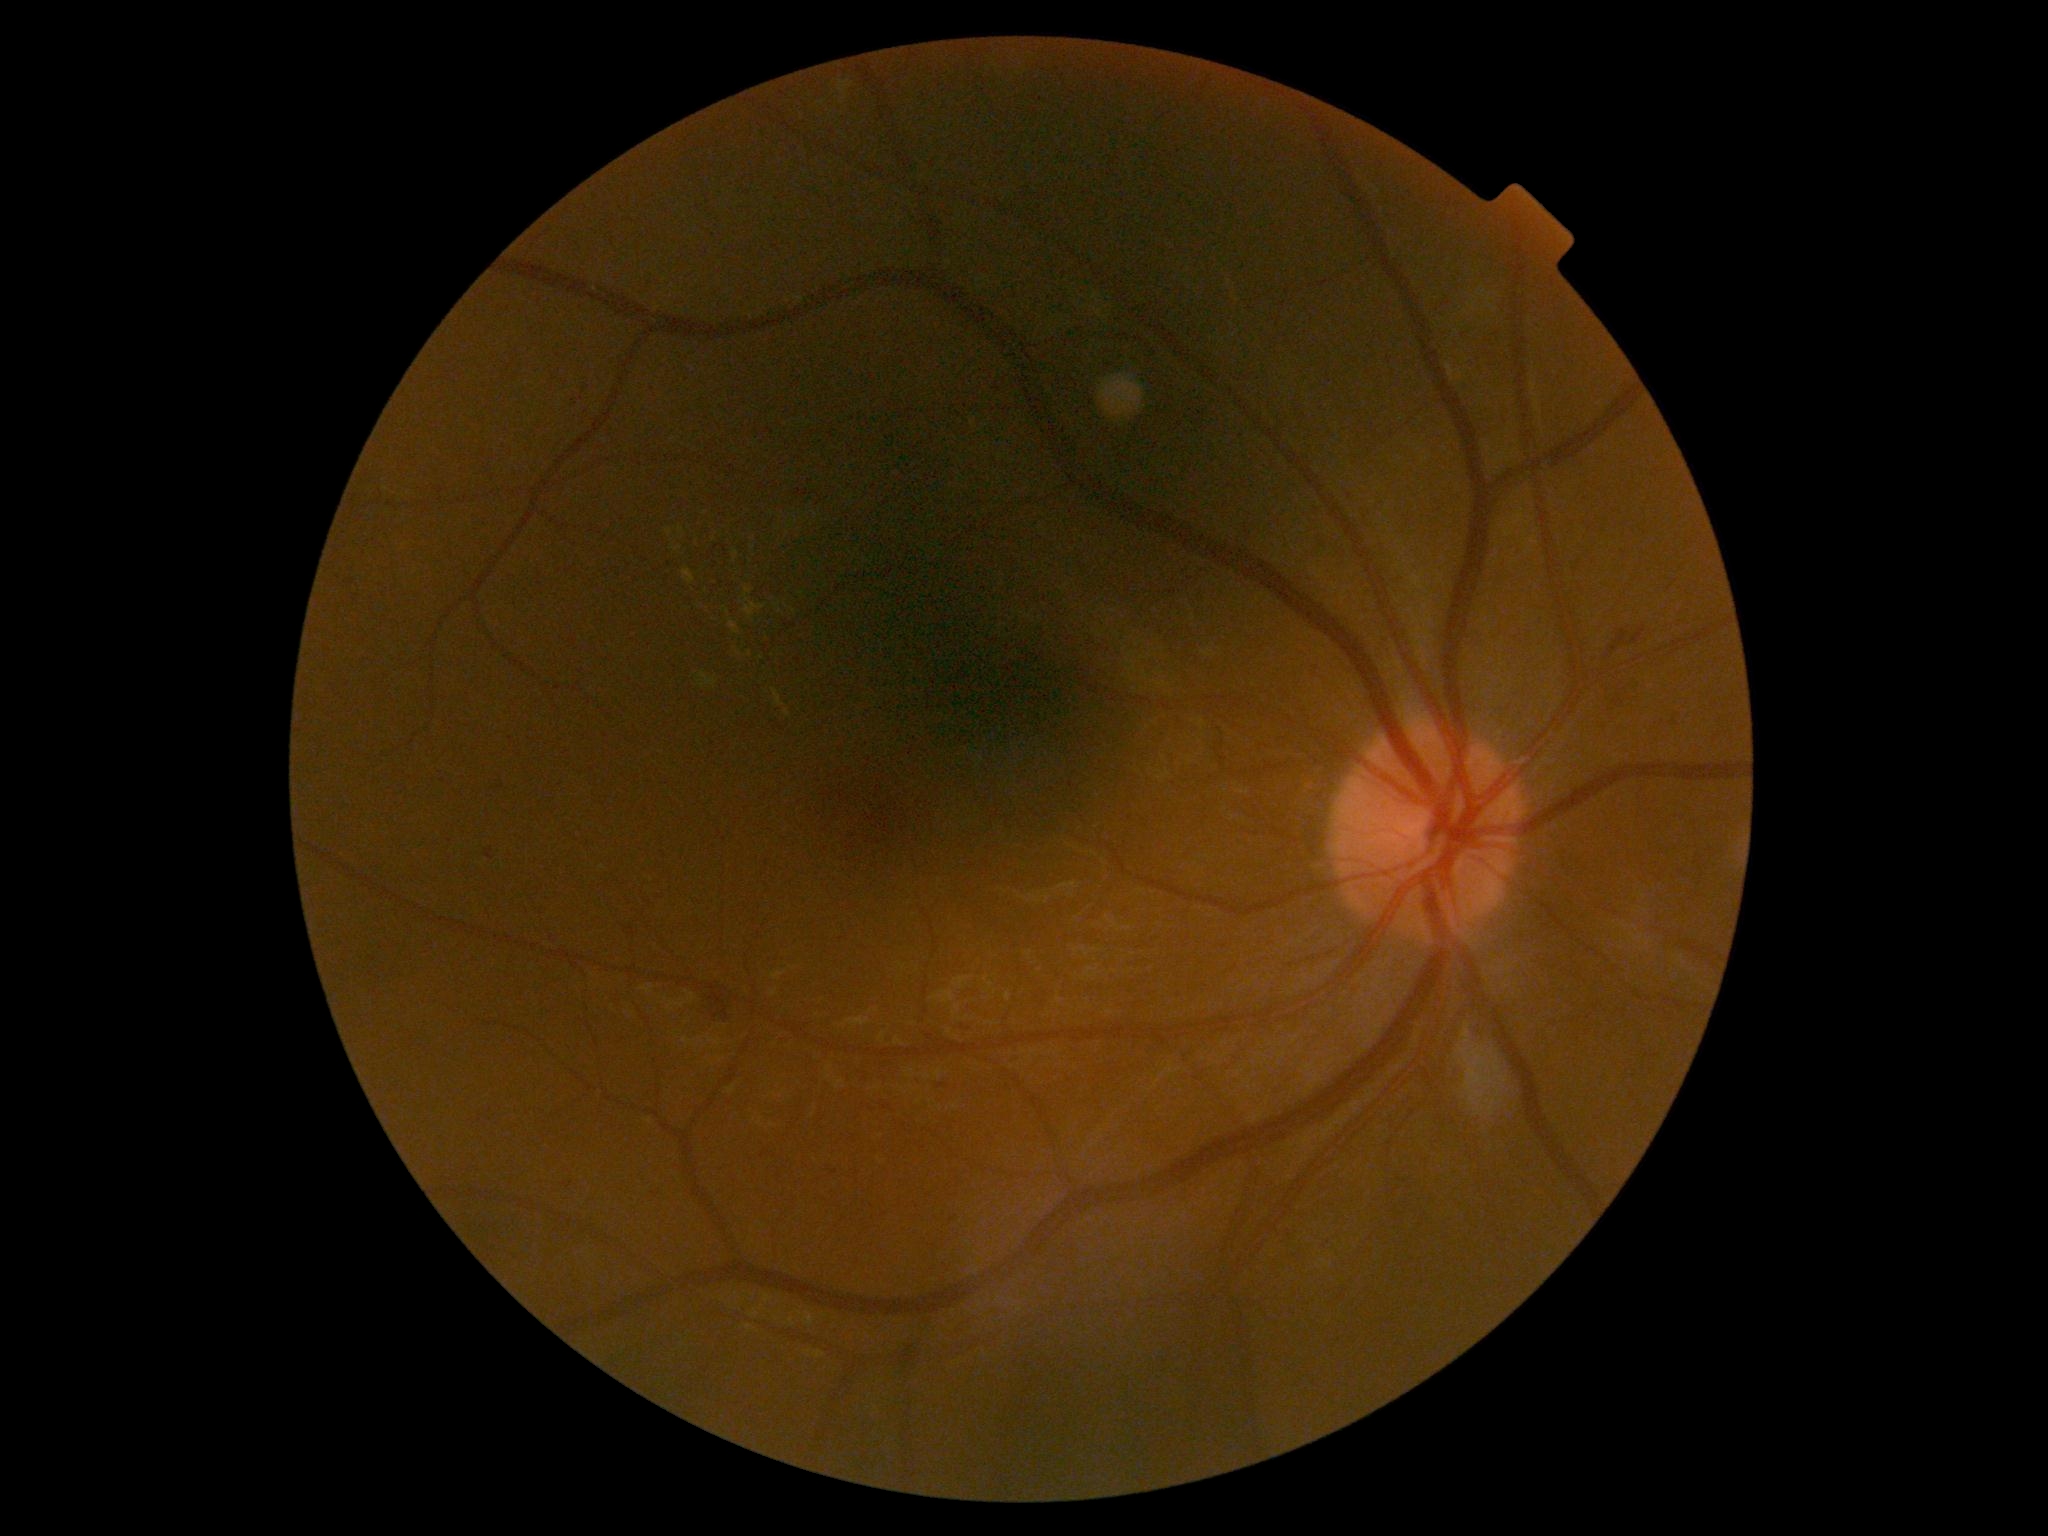 The retinopathy is classified as non-proliferative diabetic retinopathy.
Retinopathy grade is 2 (moderate NPDR).